Fundus photo; 2184x1690
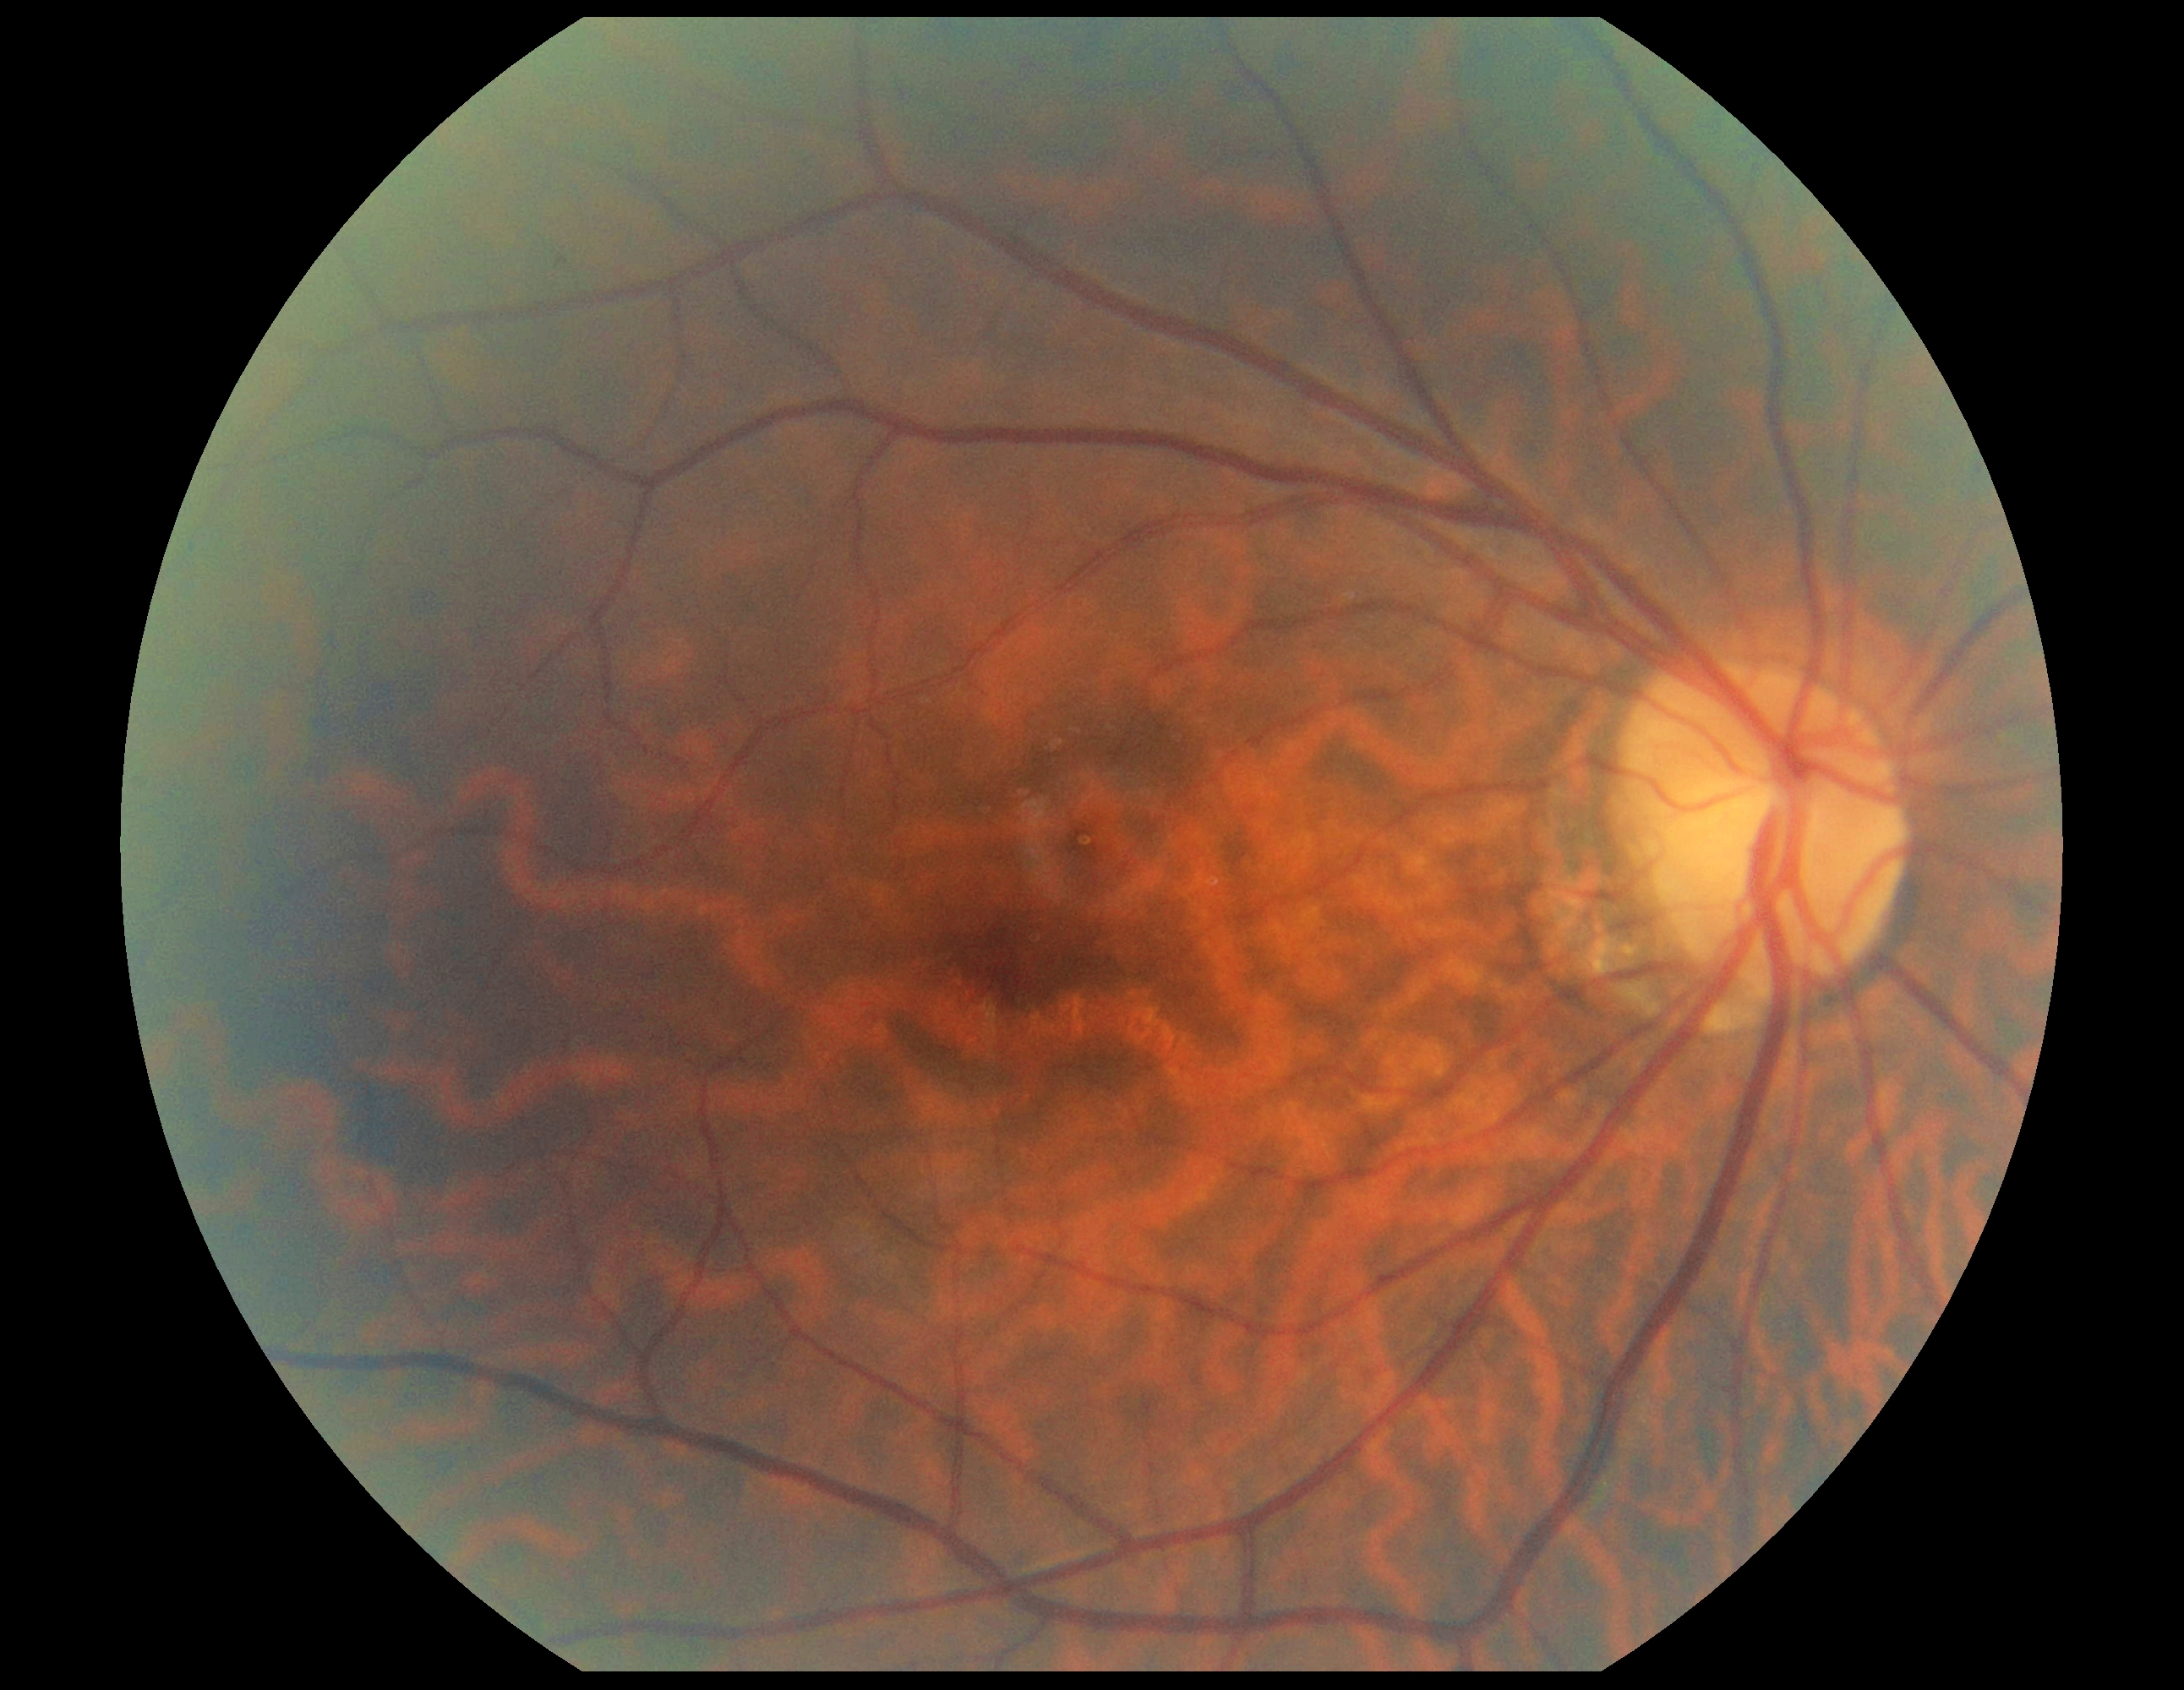 DR stage: no apparent diabetic retinopathy (grade 0).